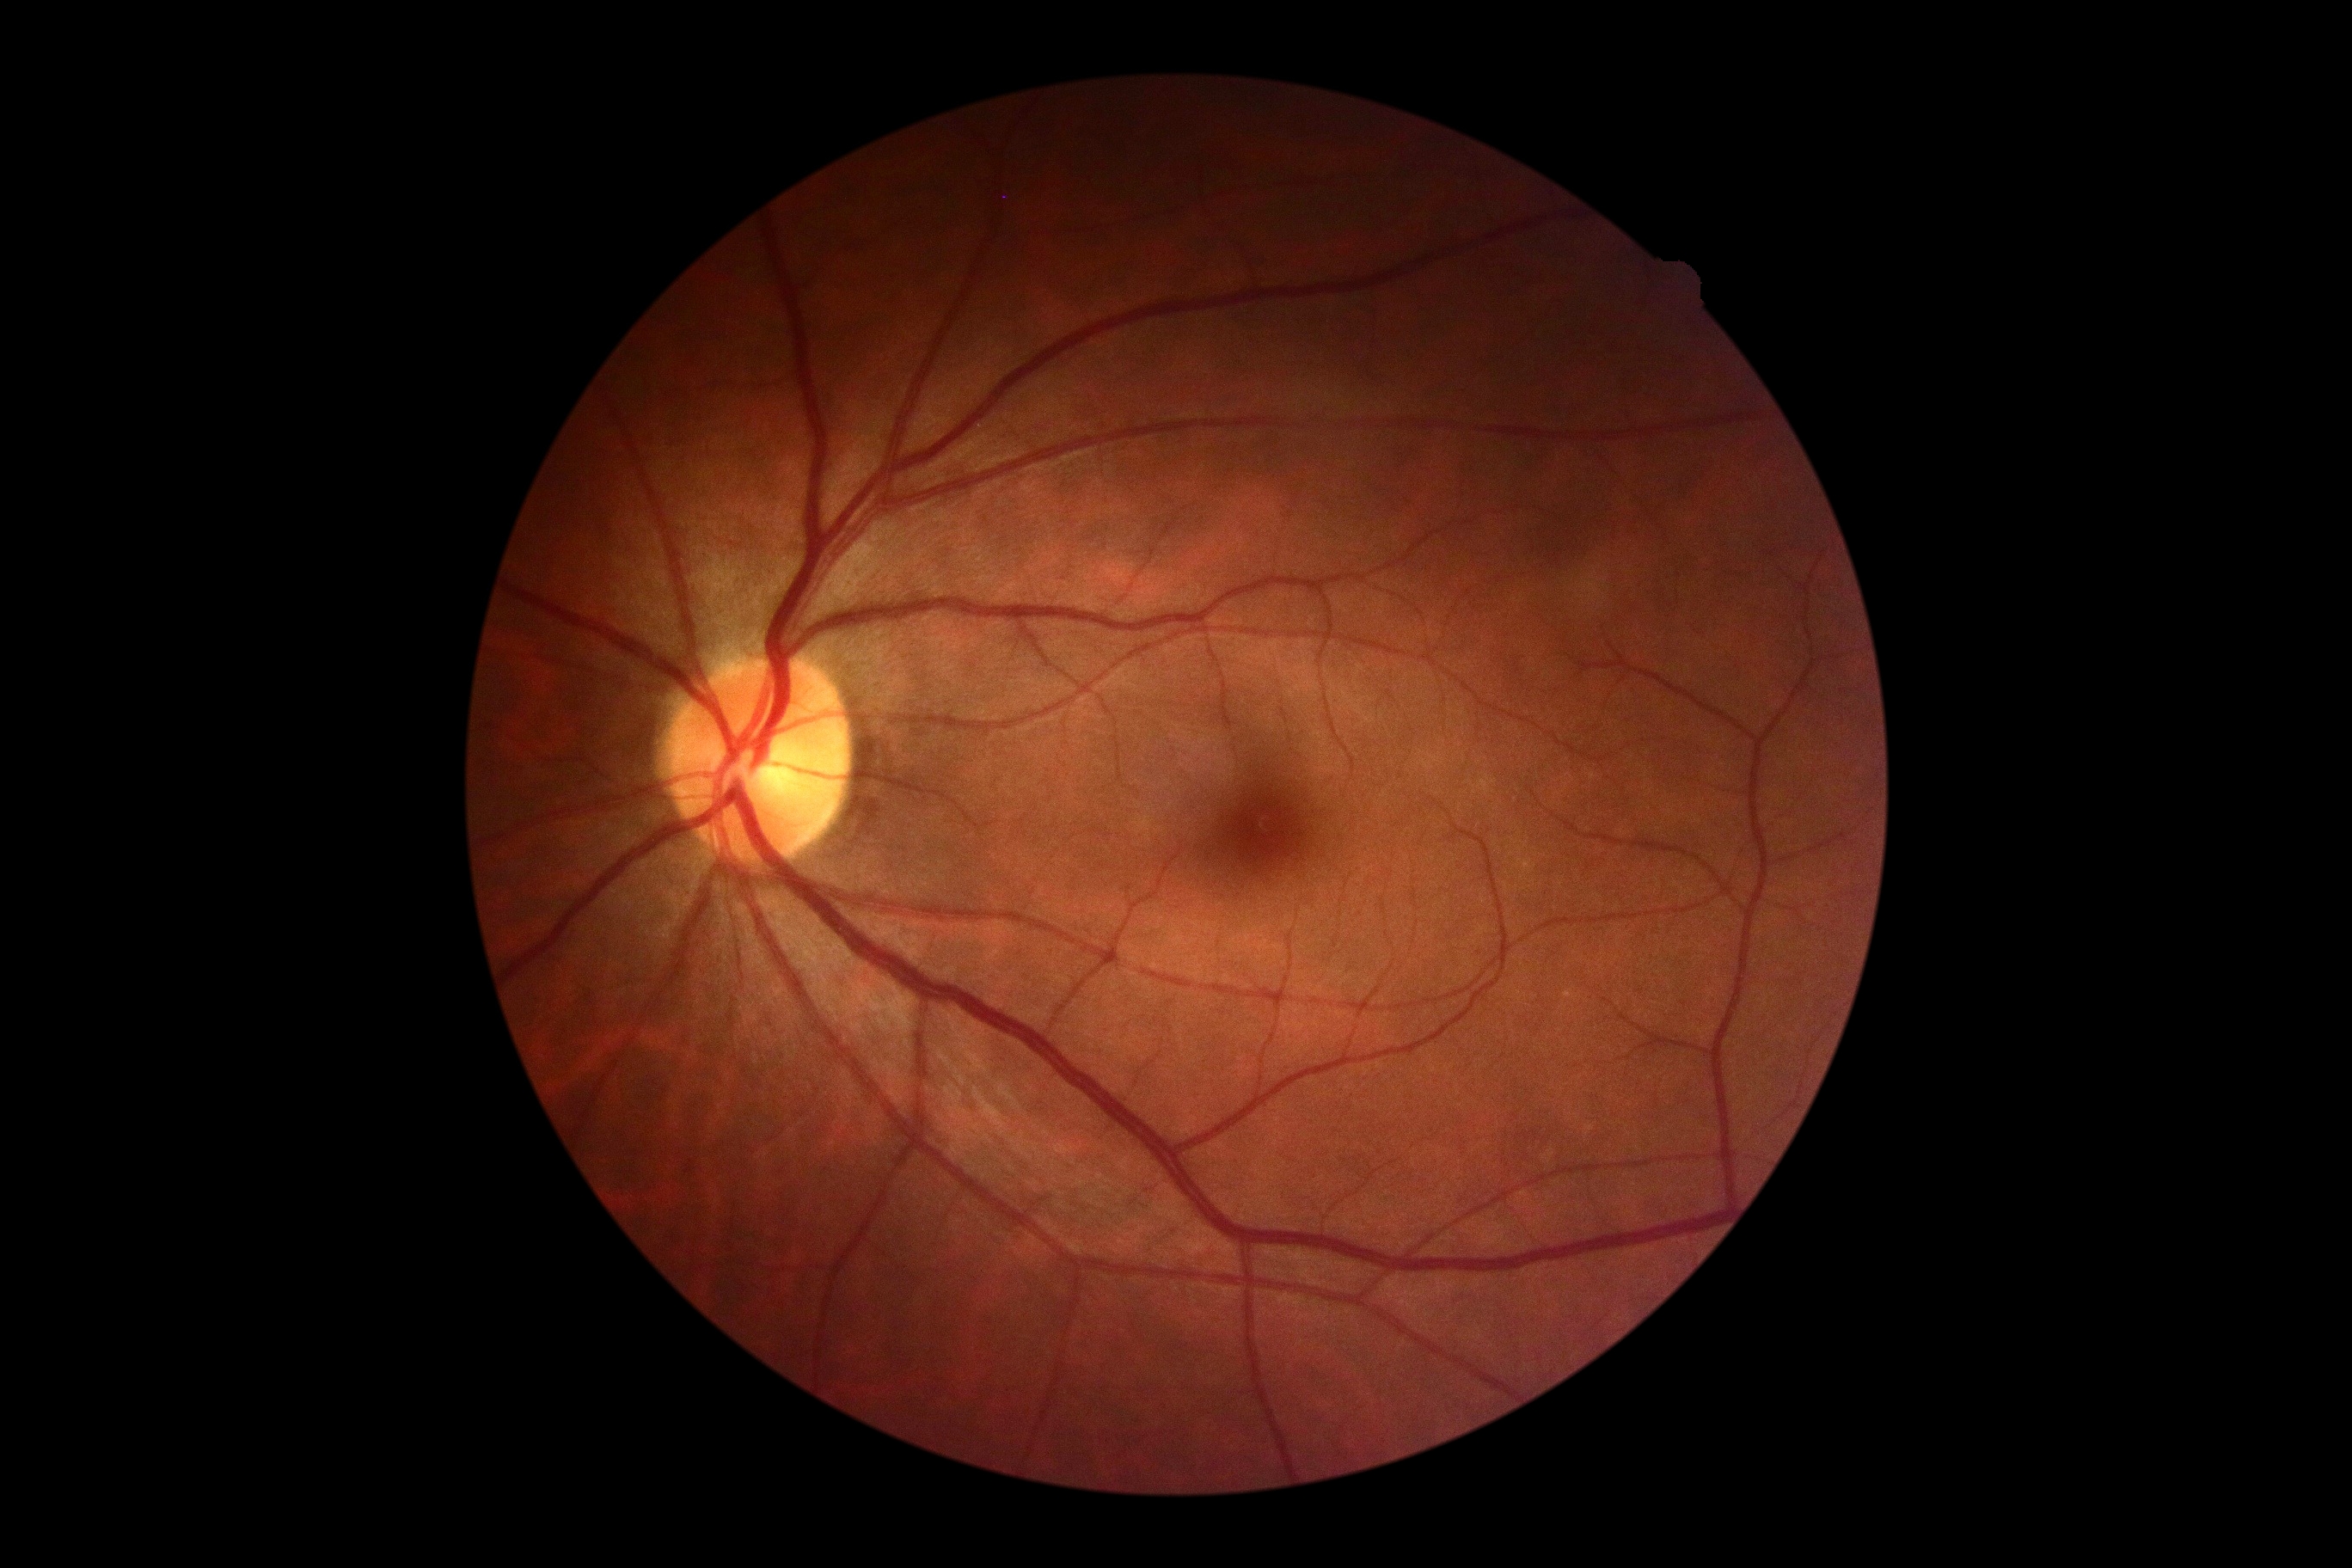 Diabetic retinopathy (DR) is grade 0 (no apparent retinopathy) — no visible signs of diabetic retinopathy.